45° FOV.
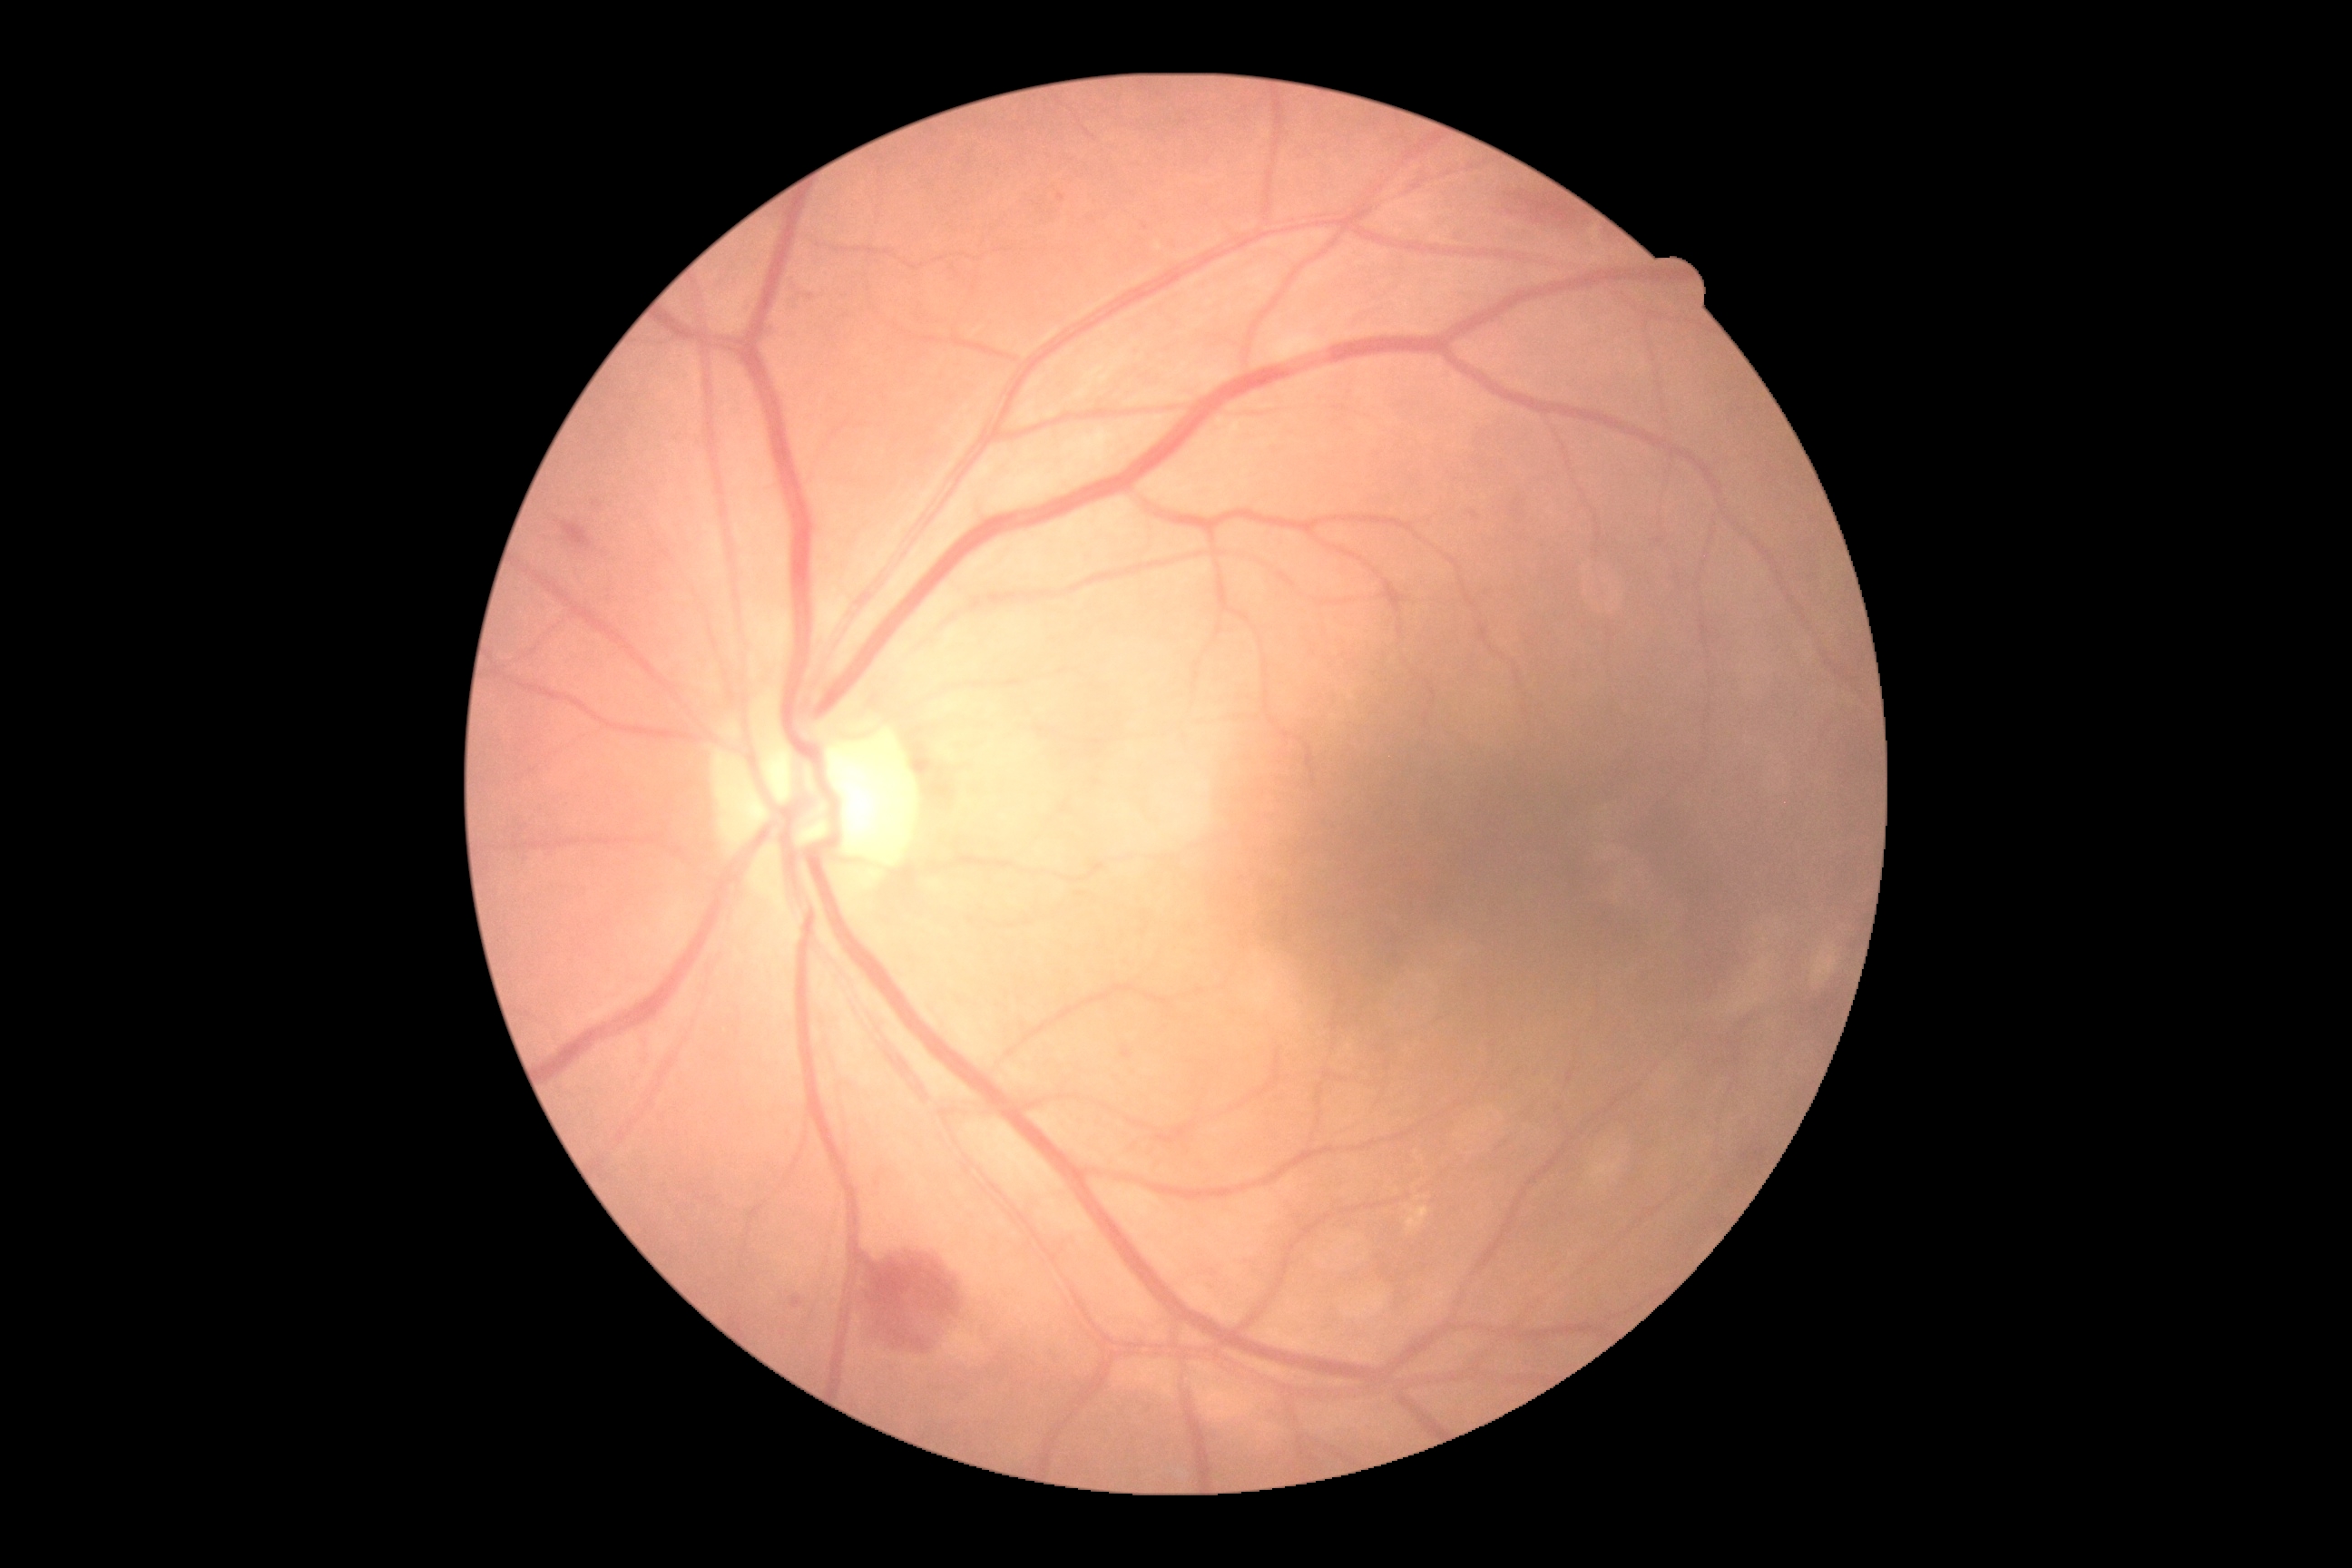

DR stage is 2.